Camera: NIDEK AFC-230, image size 848x848, color fundus image, FOV: 45 degrees: 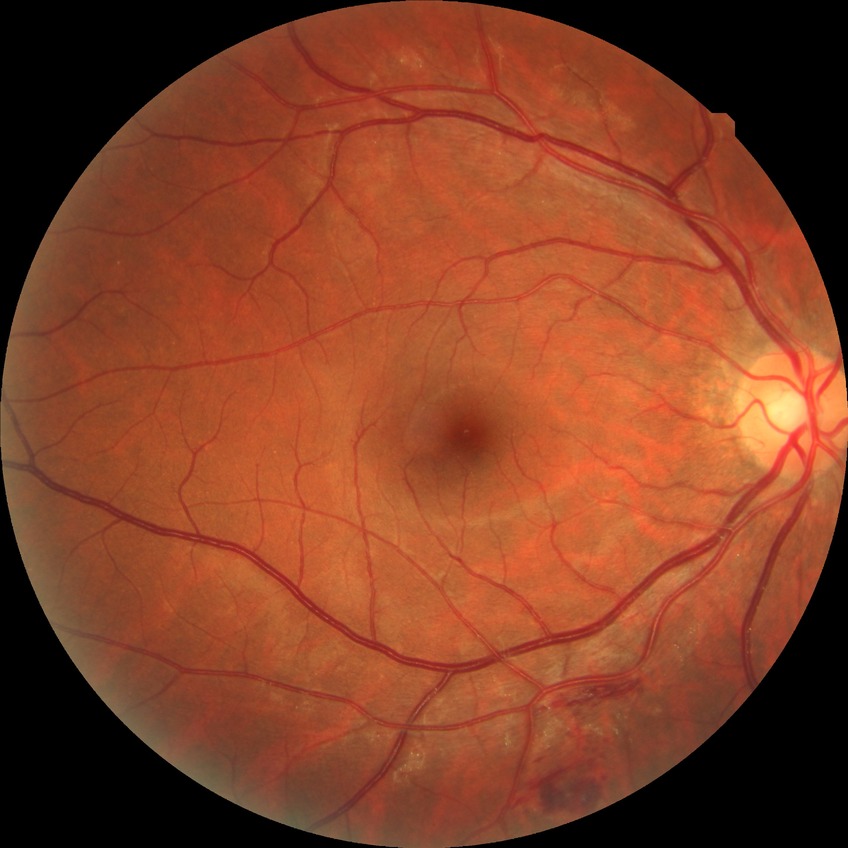 diabetic retinopathy (DR): no diabetic retinopathy (NDR).